Modified Davis classification. NIDEK AFC-230 fundus camera. Image size 848x848
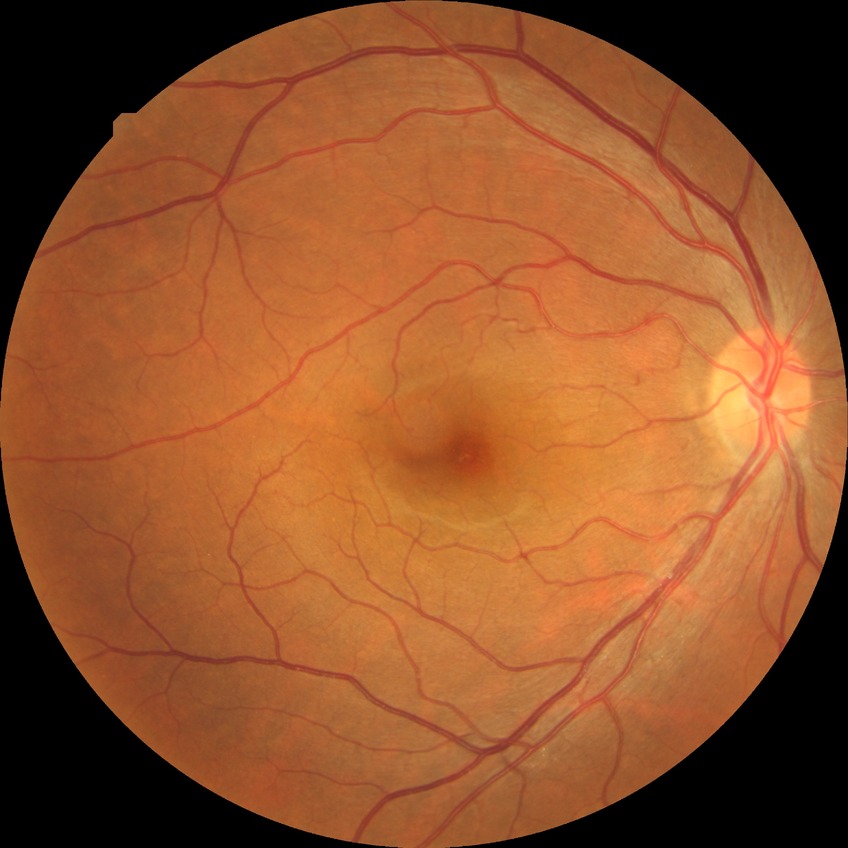
Annotations:
* diabetic retinopathy severity — no diabetic retinopathy